Wide-field fundus photograph of an infant:
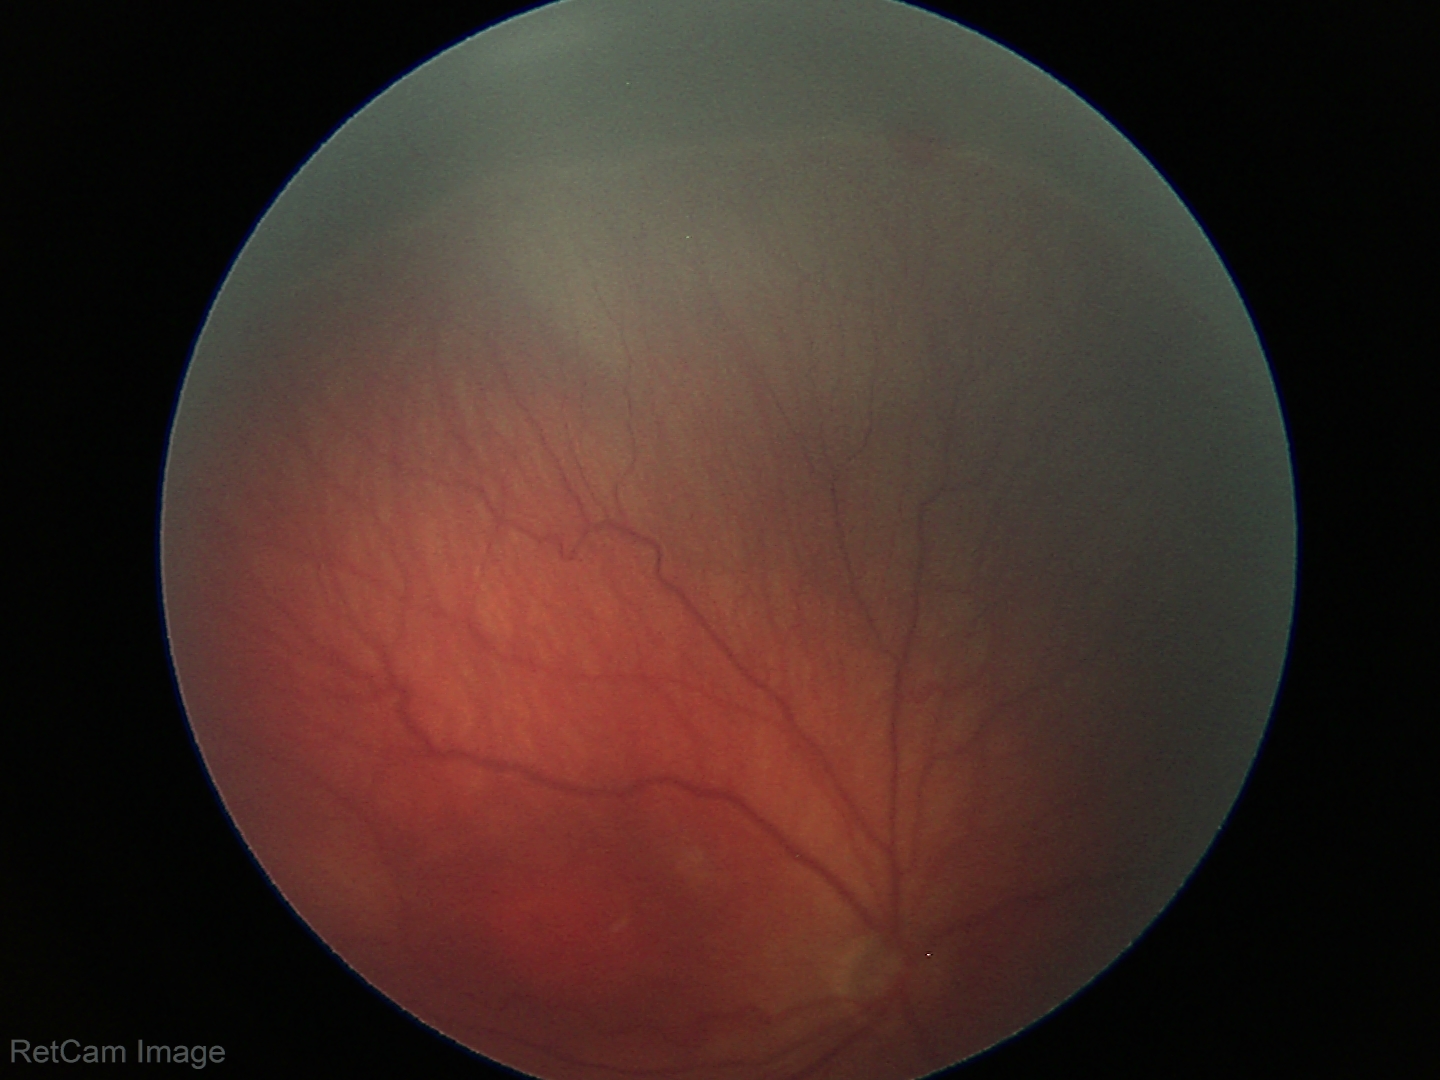 Plus disease absent.
Screening series with ROP stage 3 — ridge with extraretinal fibrovascular proliferation.